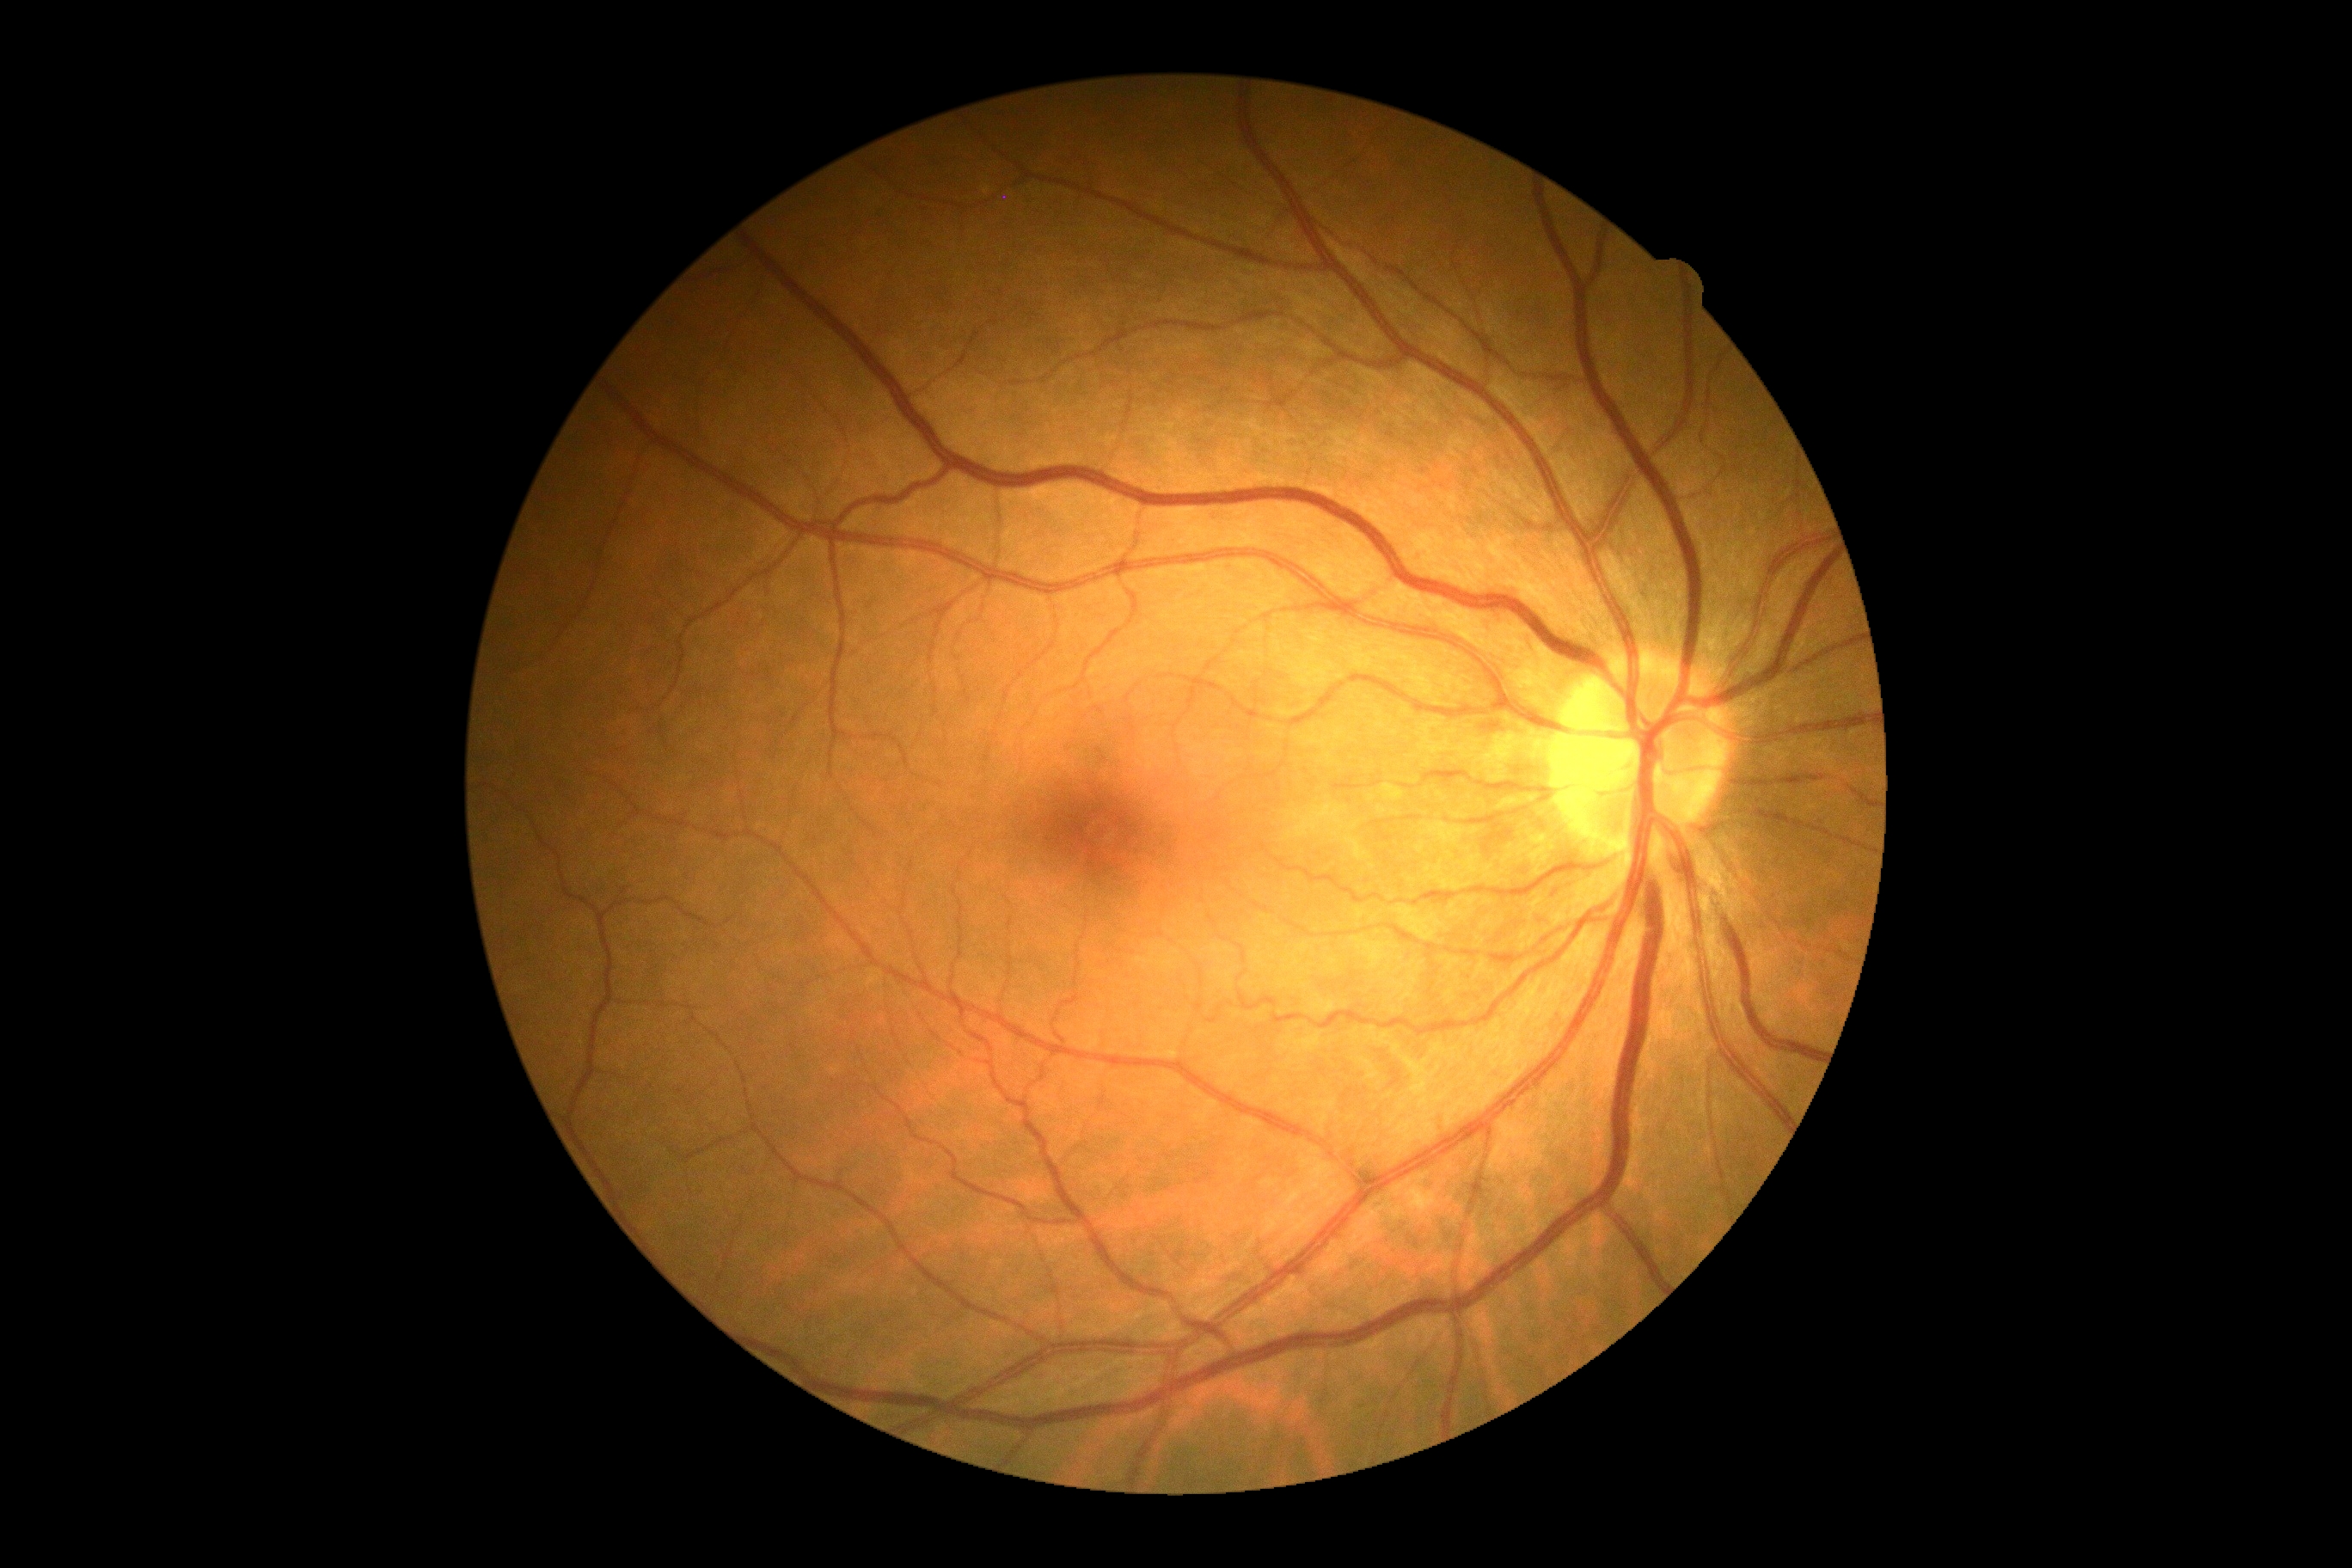
DR grade: 0.